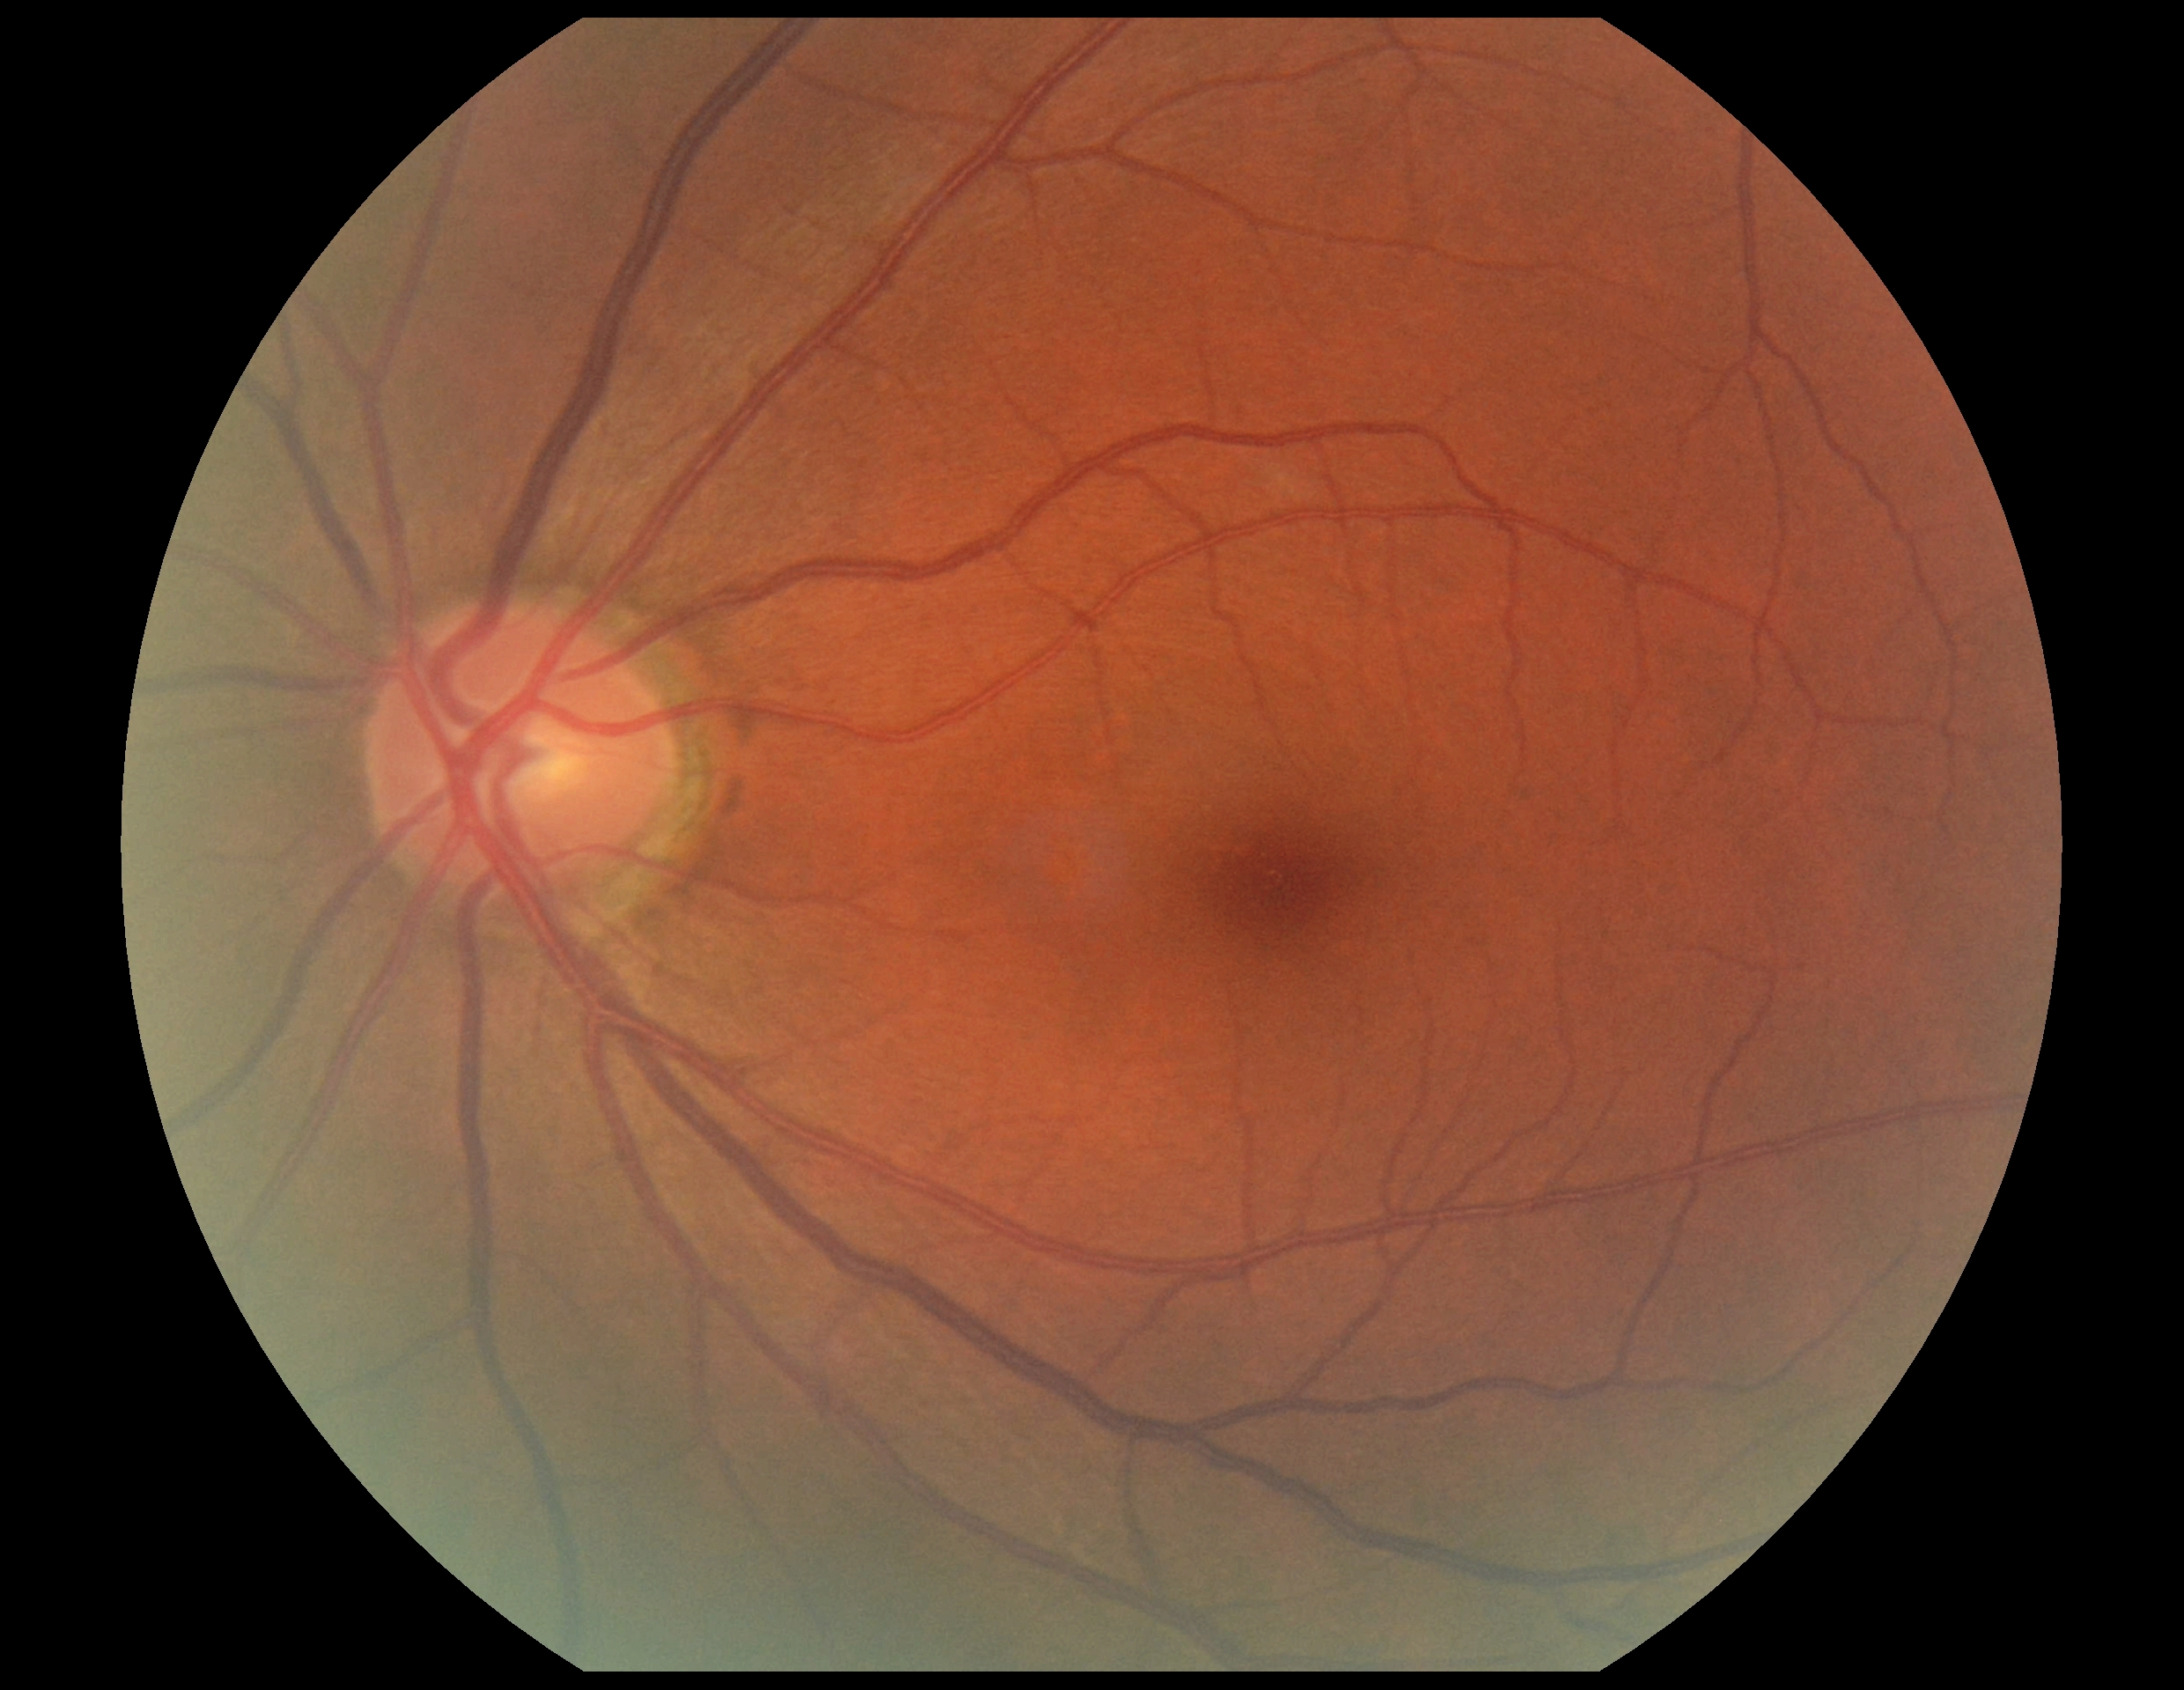
No DR findings. DR severity: no apparent retinopathy (grade 0).